Diabetic retinopathy graded by the modified Davis classification.
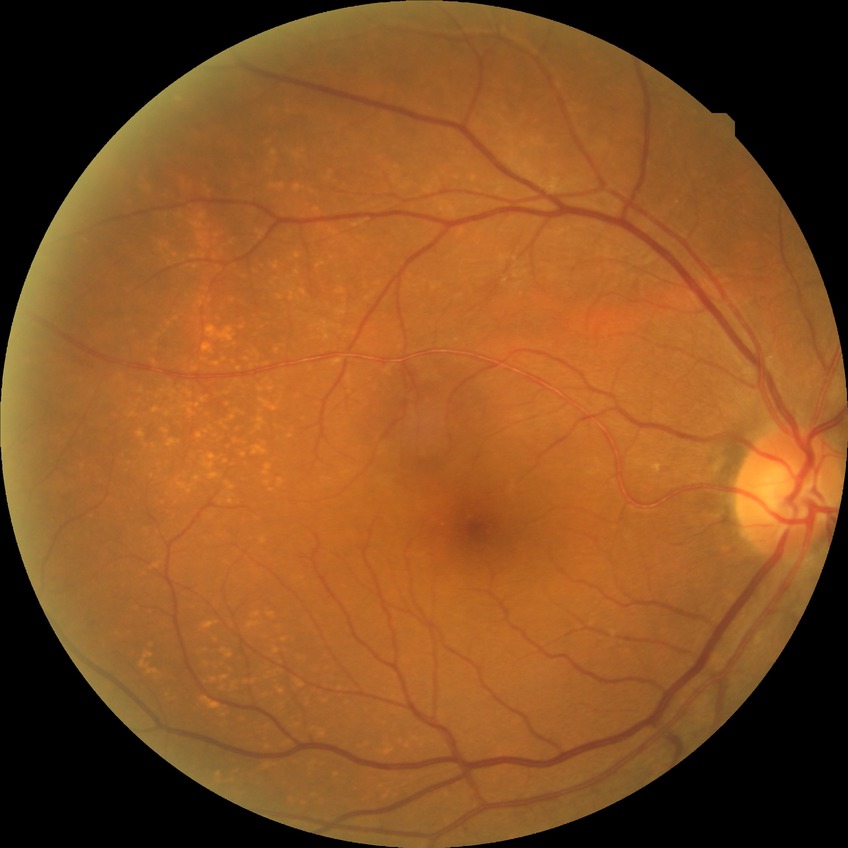
Diabetic retinopathy (DR): no diabetic retinopathy (NDR).